1932 x 1910 pixels.
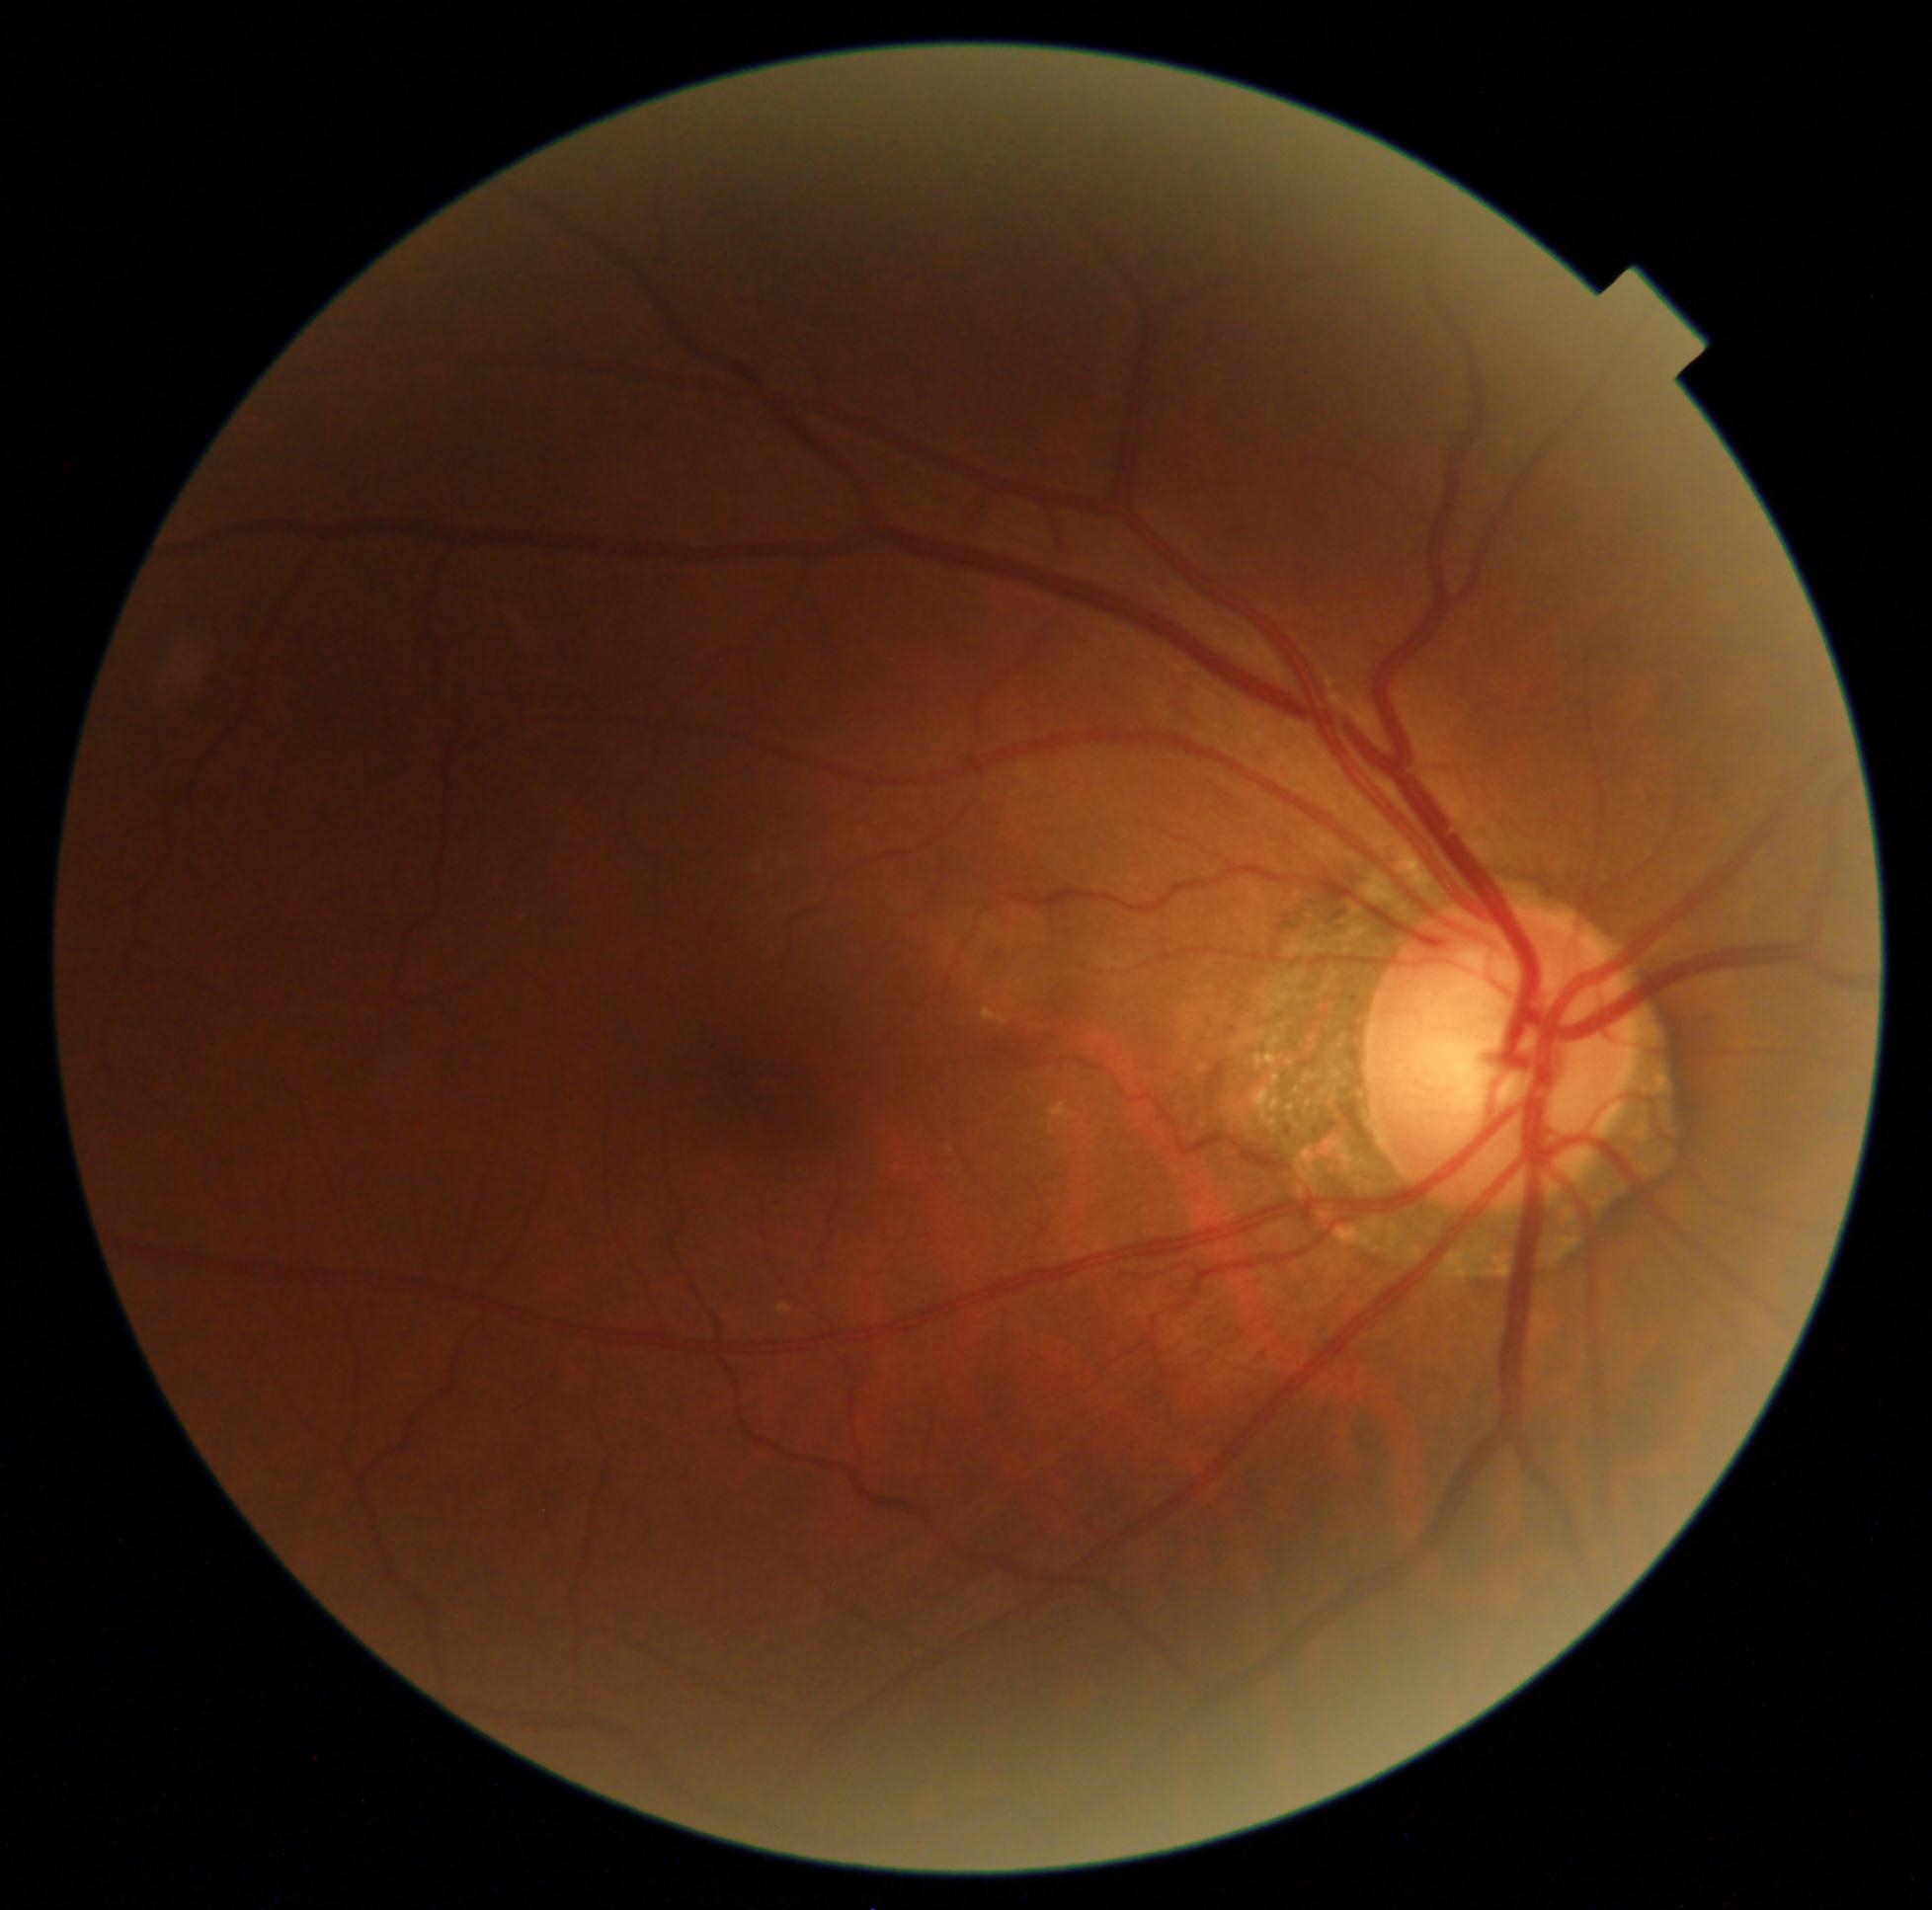

DR is 2.